45° field of view · image size 1932x1932.
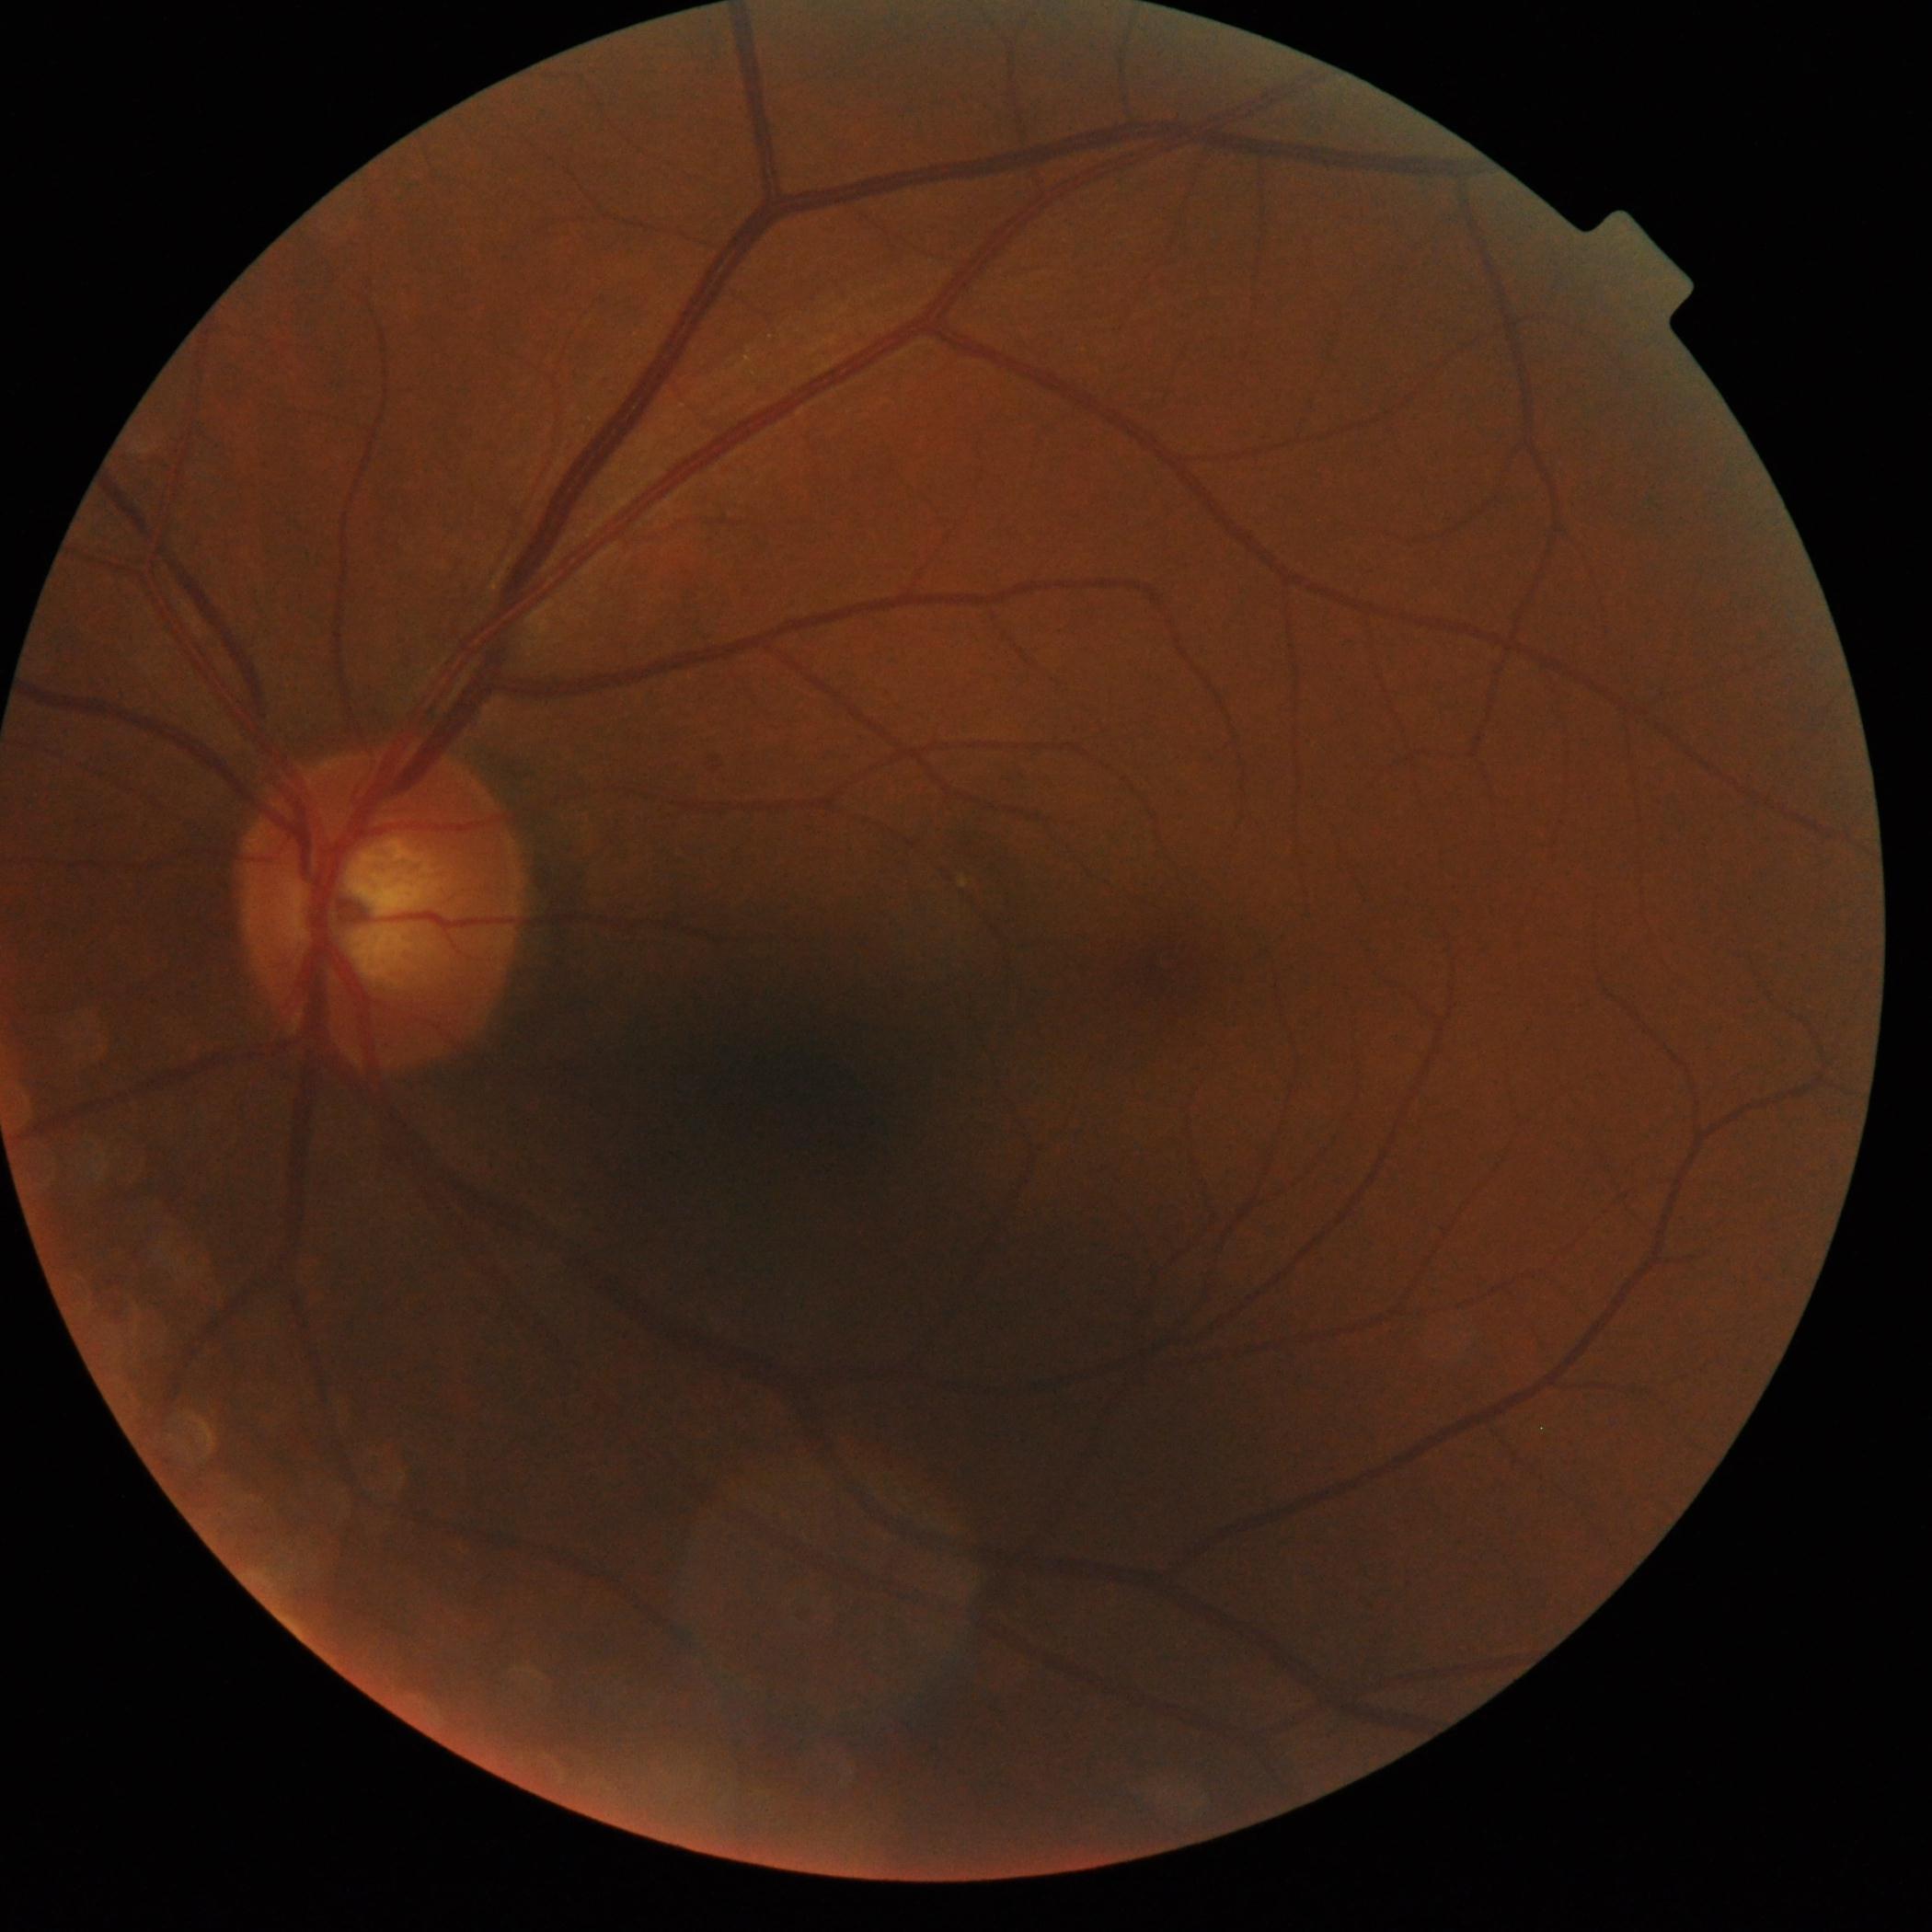 {"dr_grade": "0/4"}